Infant wide-field fundus photograph
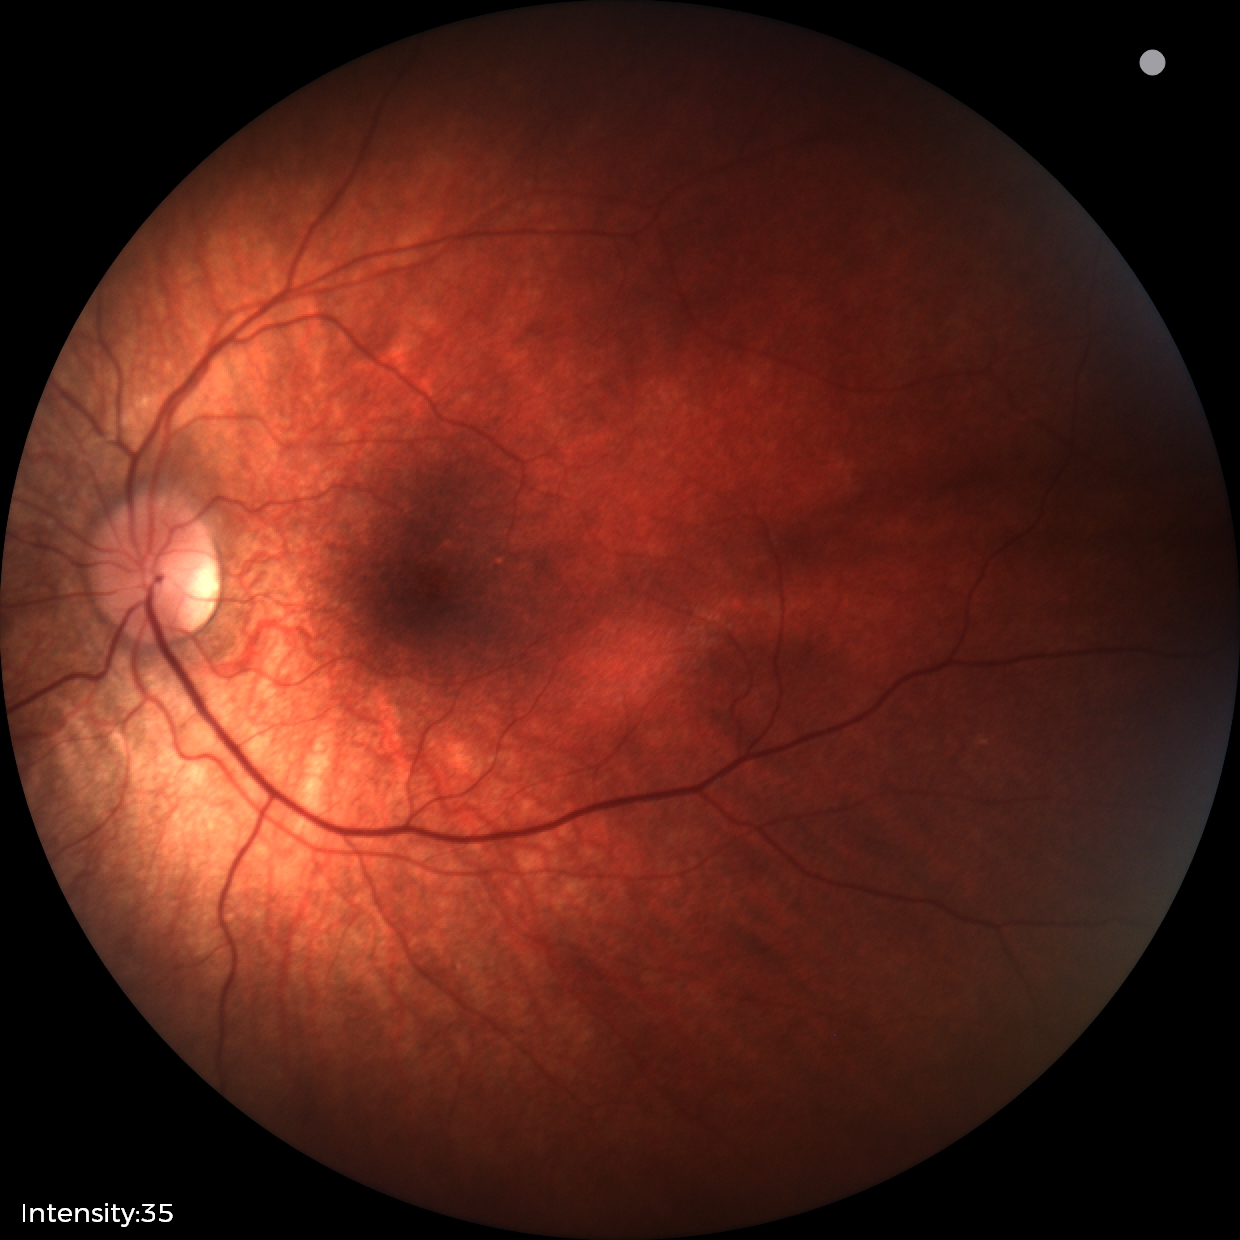 Diagnosis from this screening exam: retinal astrocytic hamartoma.